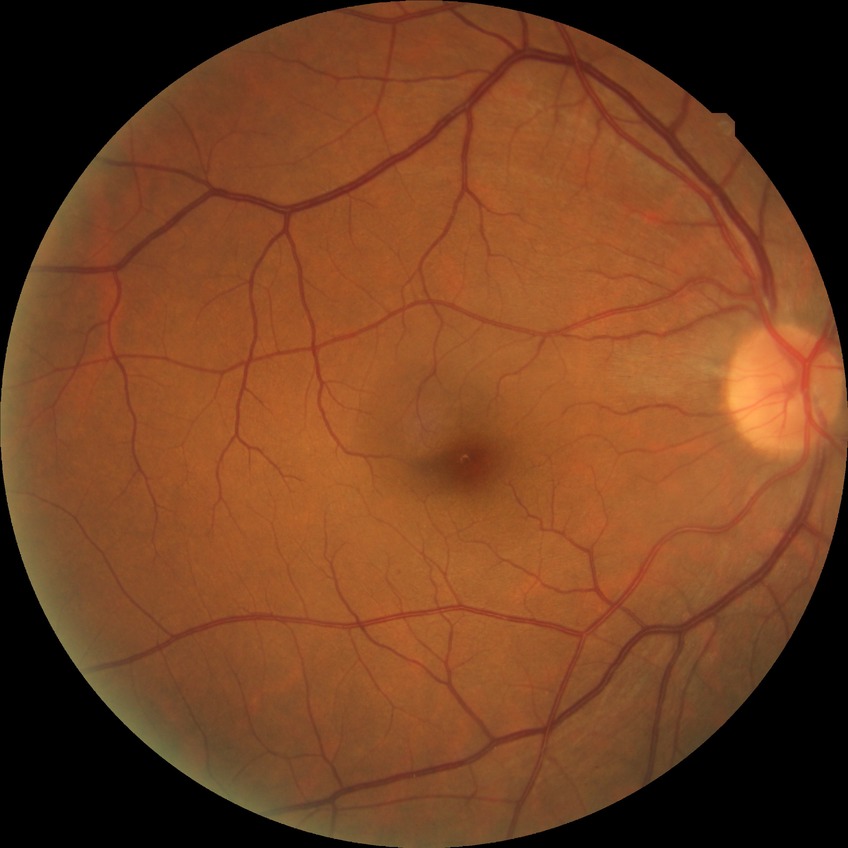

{
  "davis_grade": "SDR"
}